45° FOV.
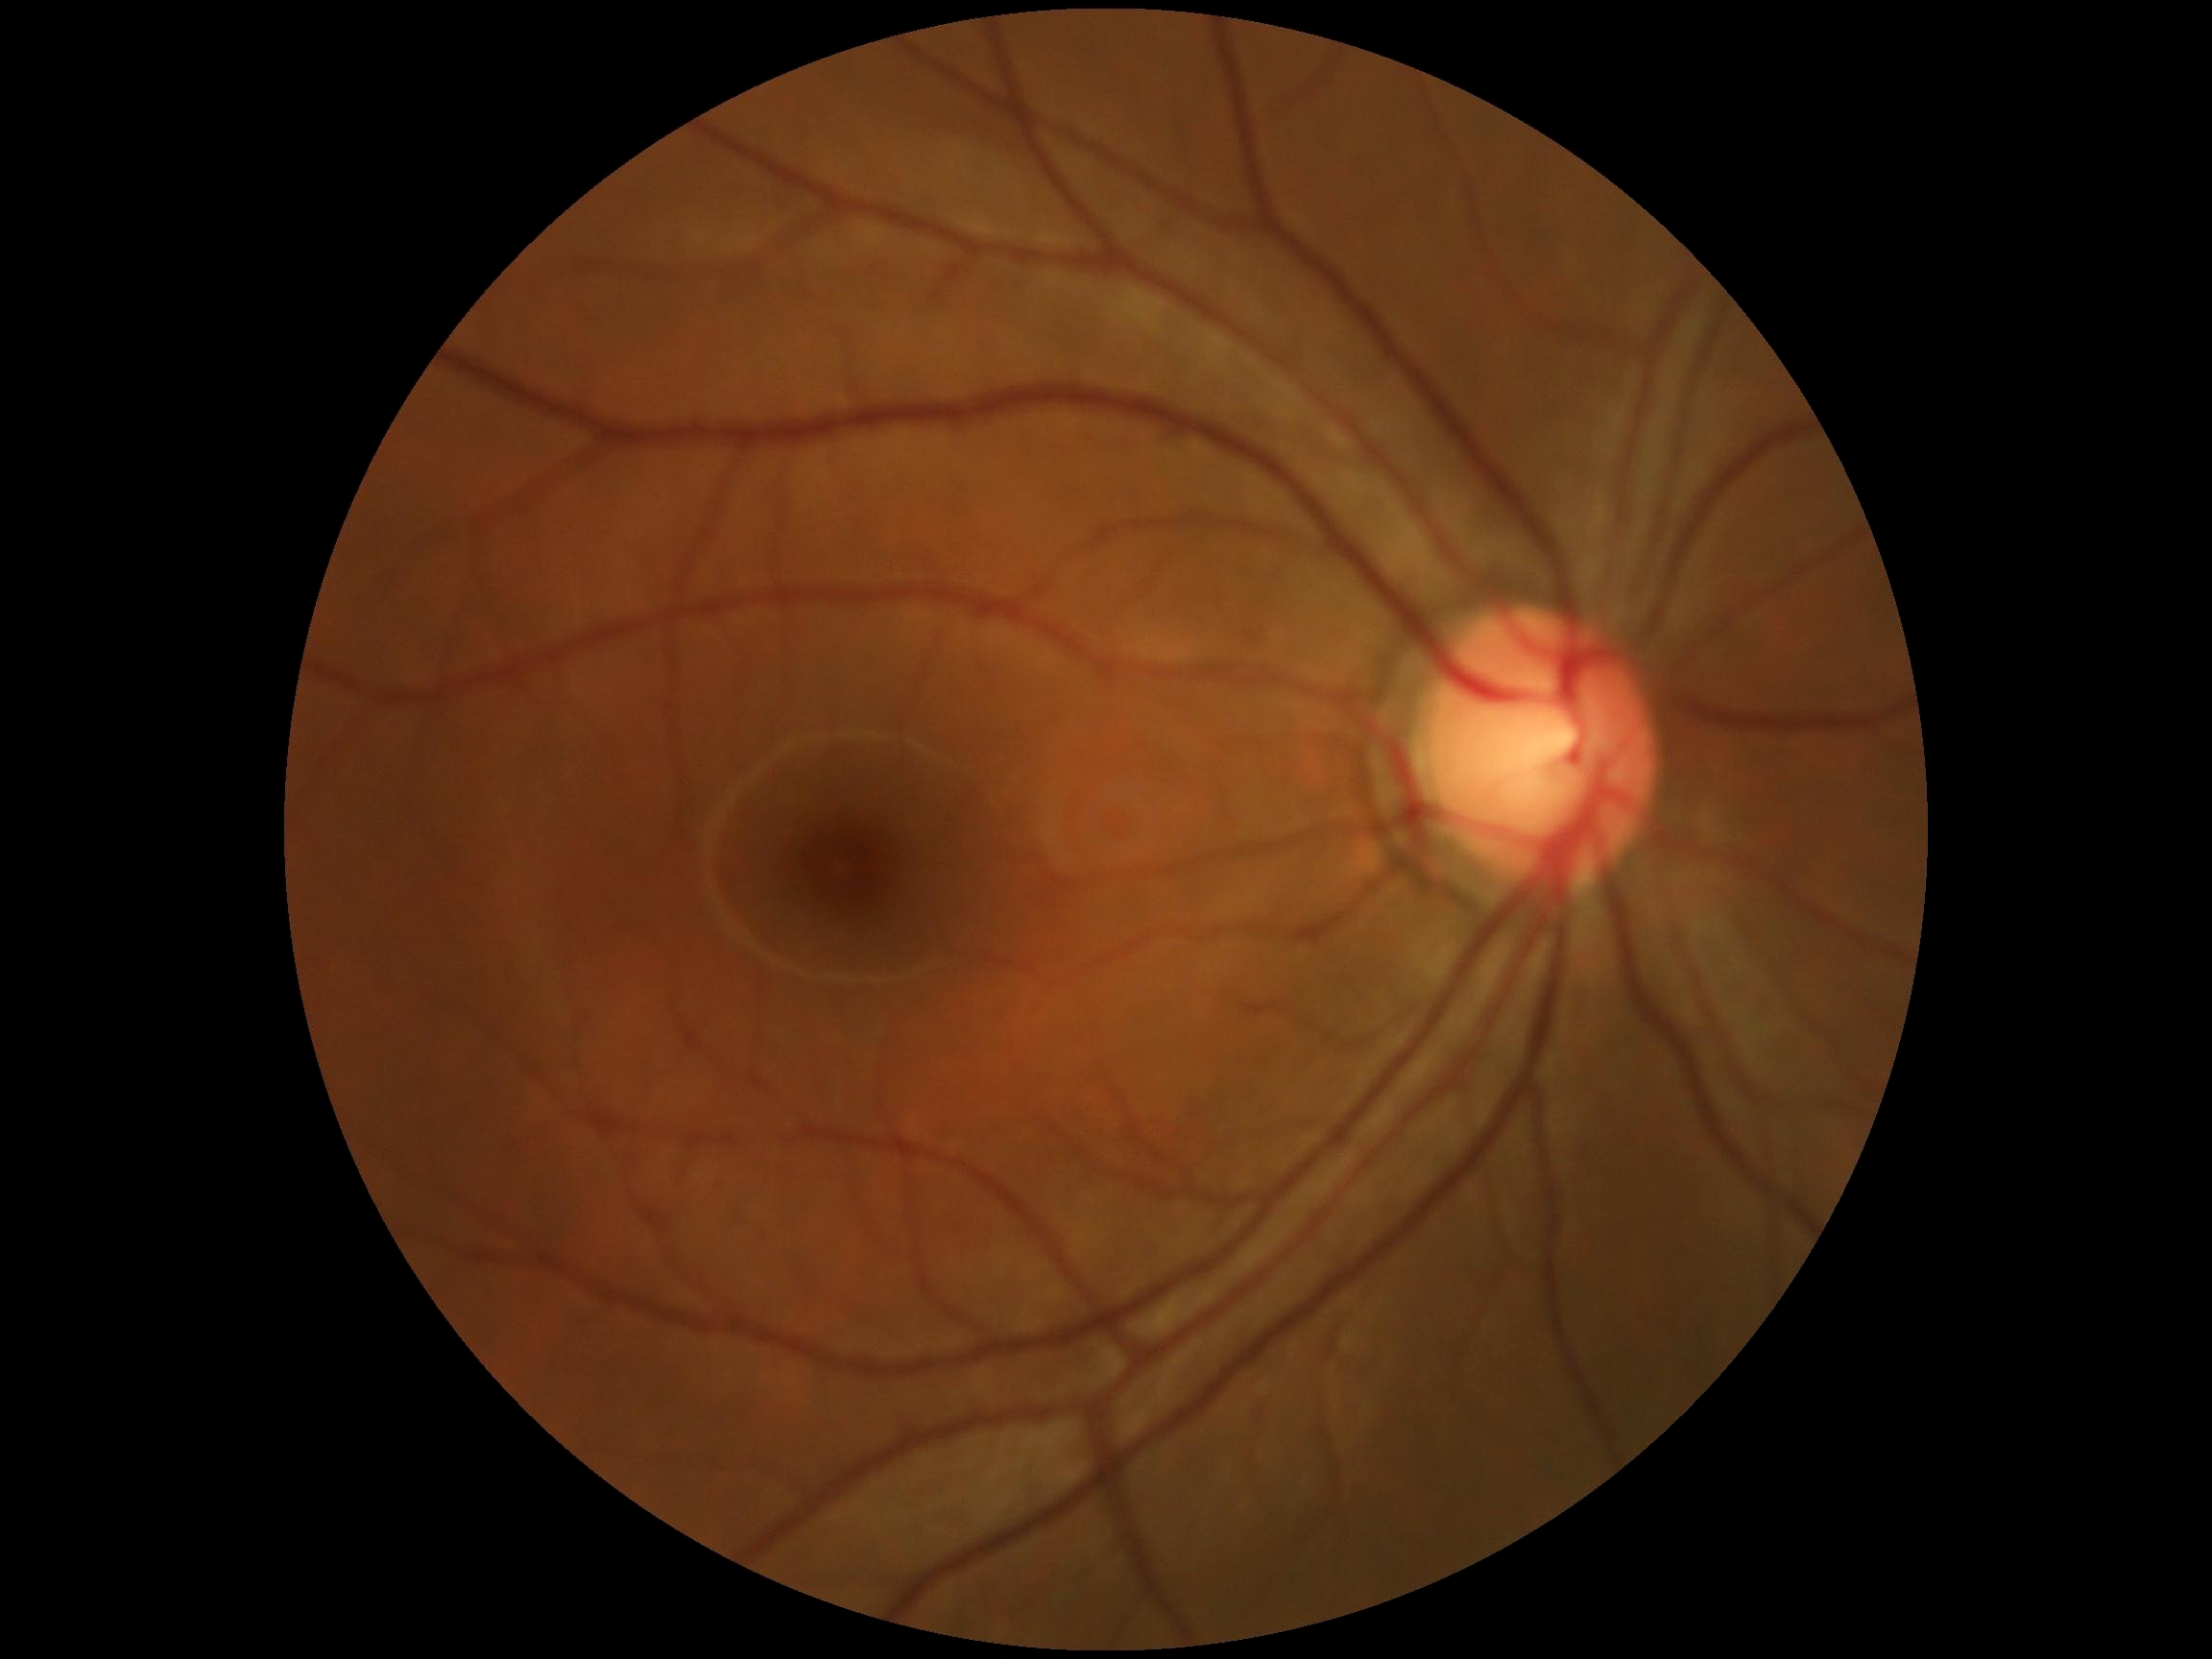
Diabetic retinopathy (DR) is 0.